Color fundus image. 45° field of view
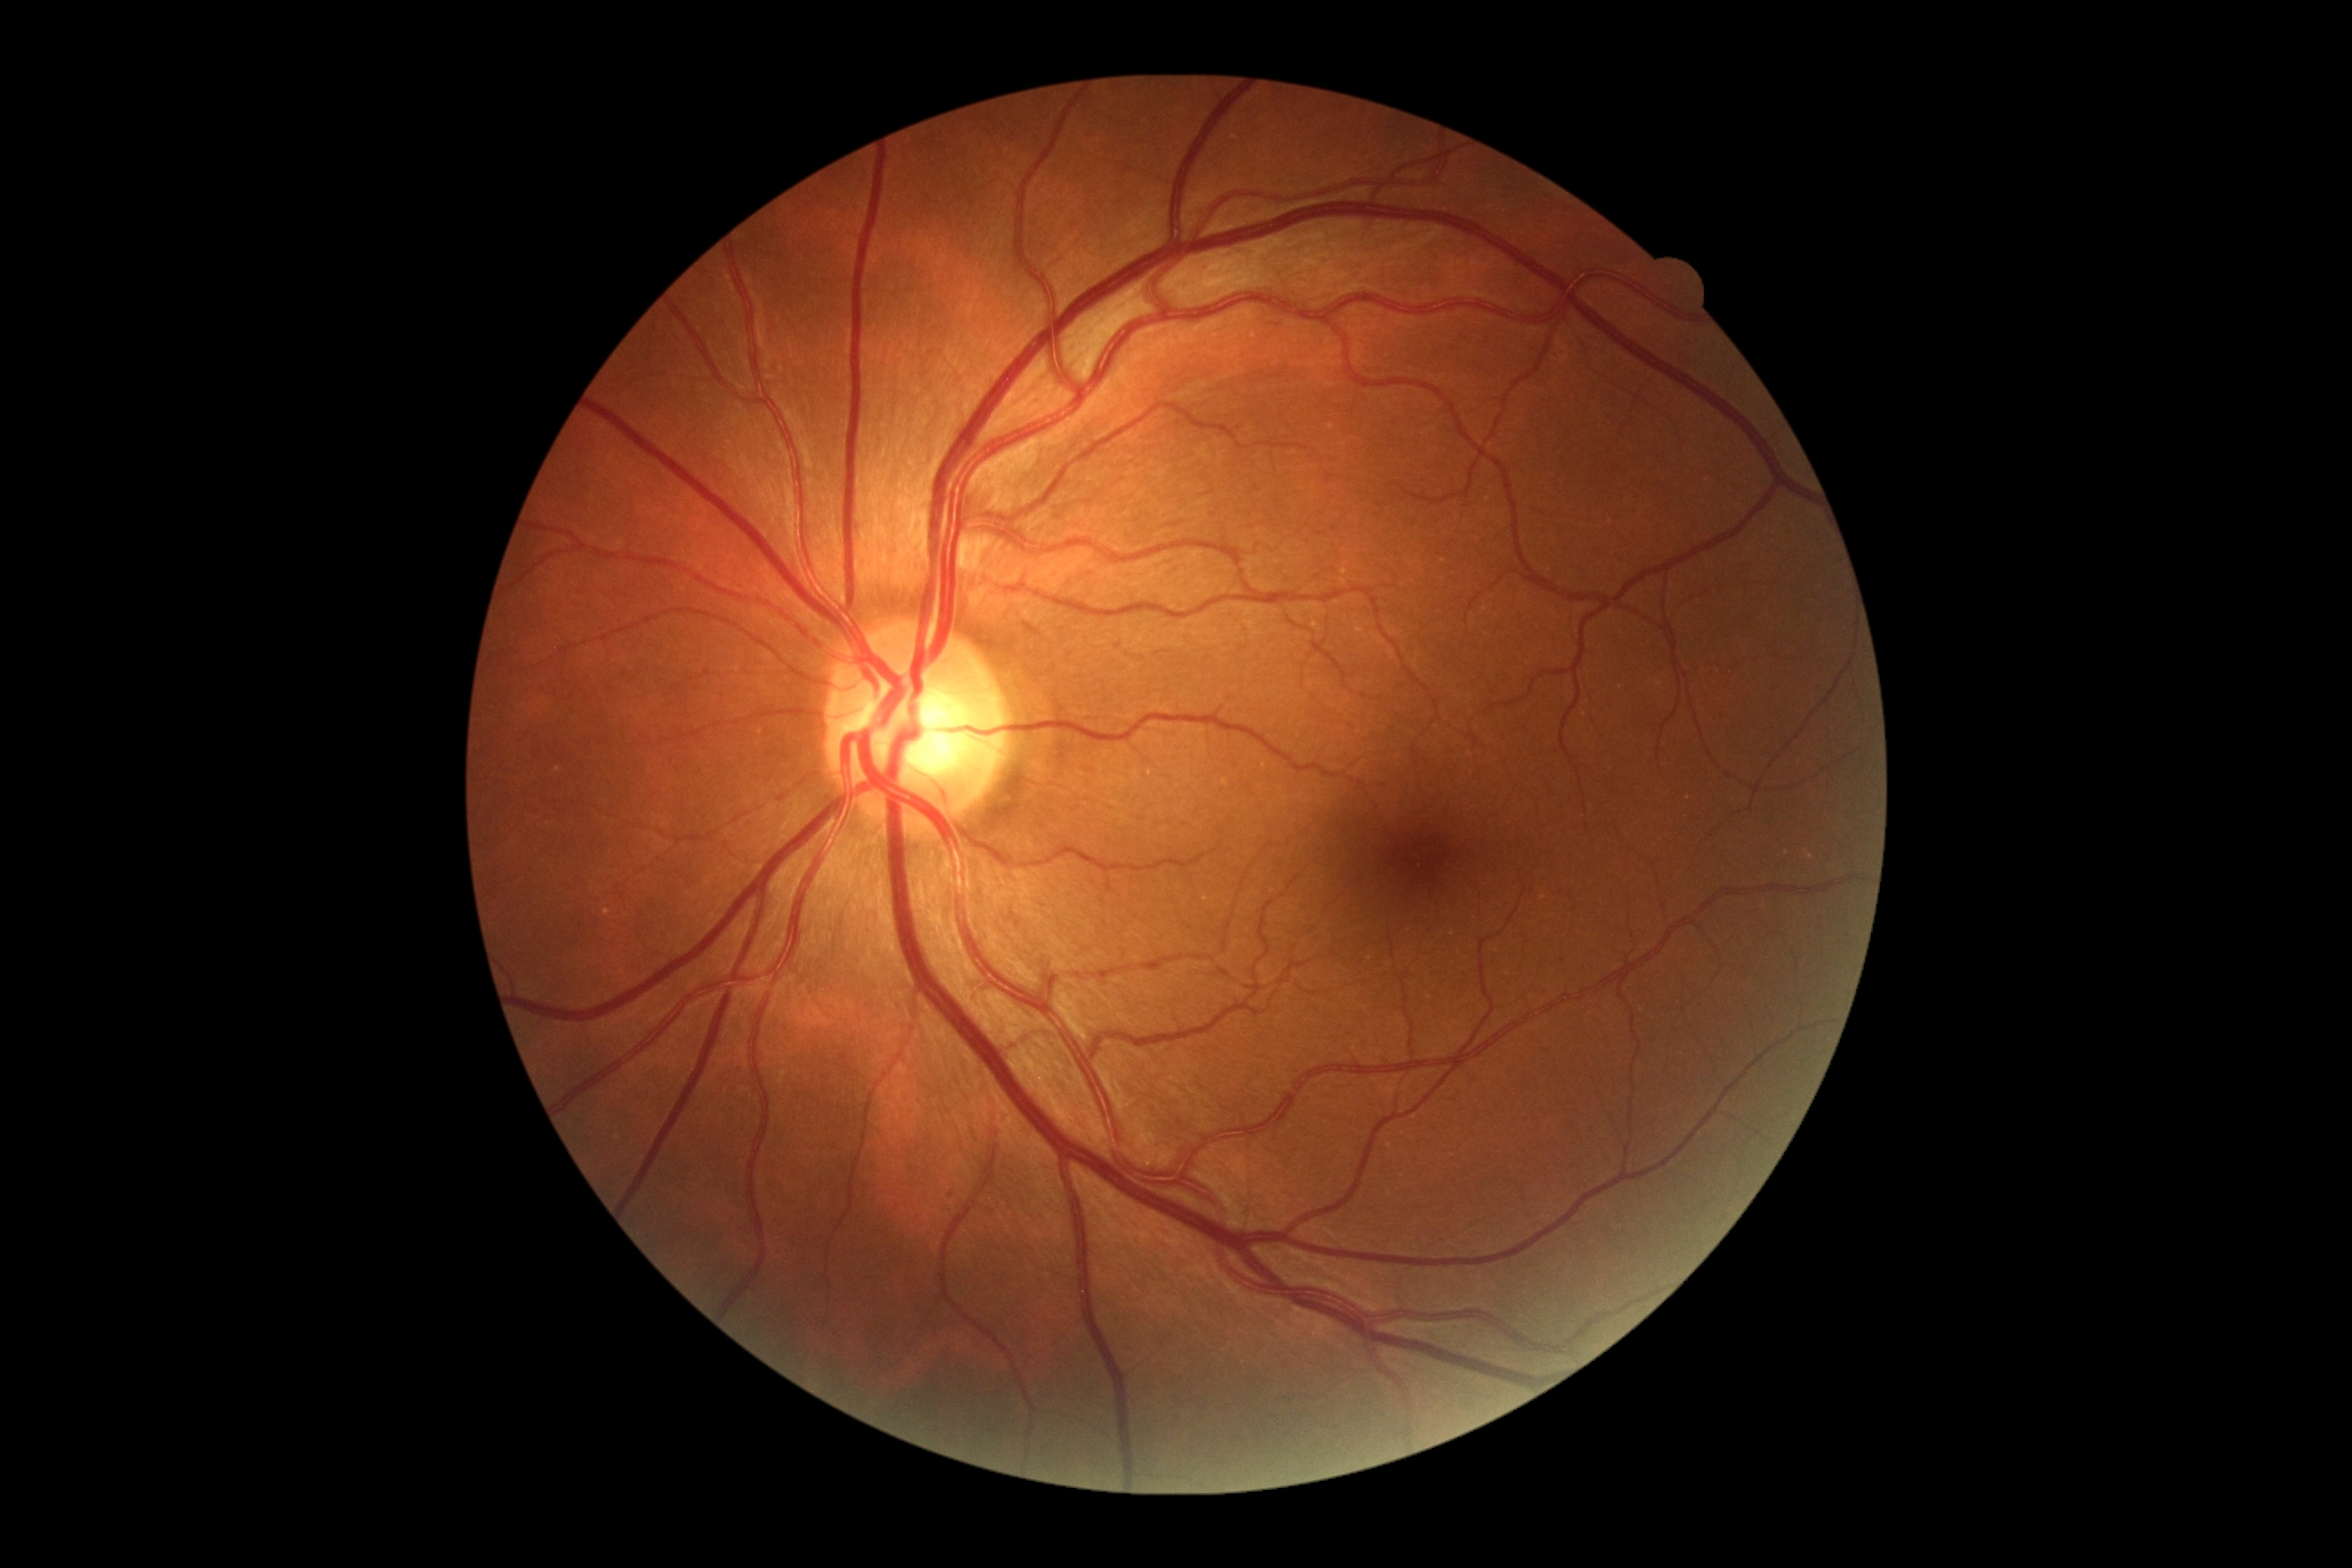
DR: no apparent retinopathy (grade 0).